Color fundus image · 45-degree field of view · 1515x1275:
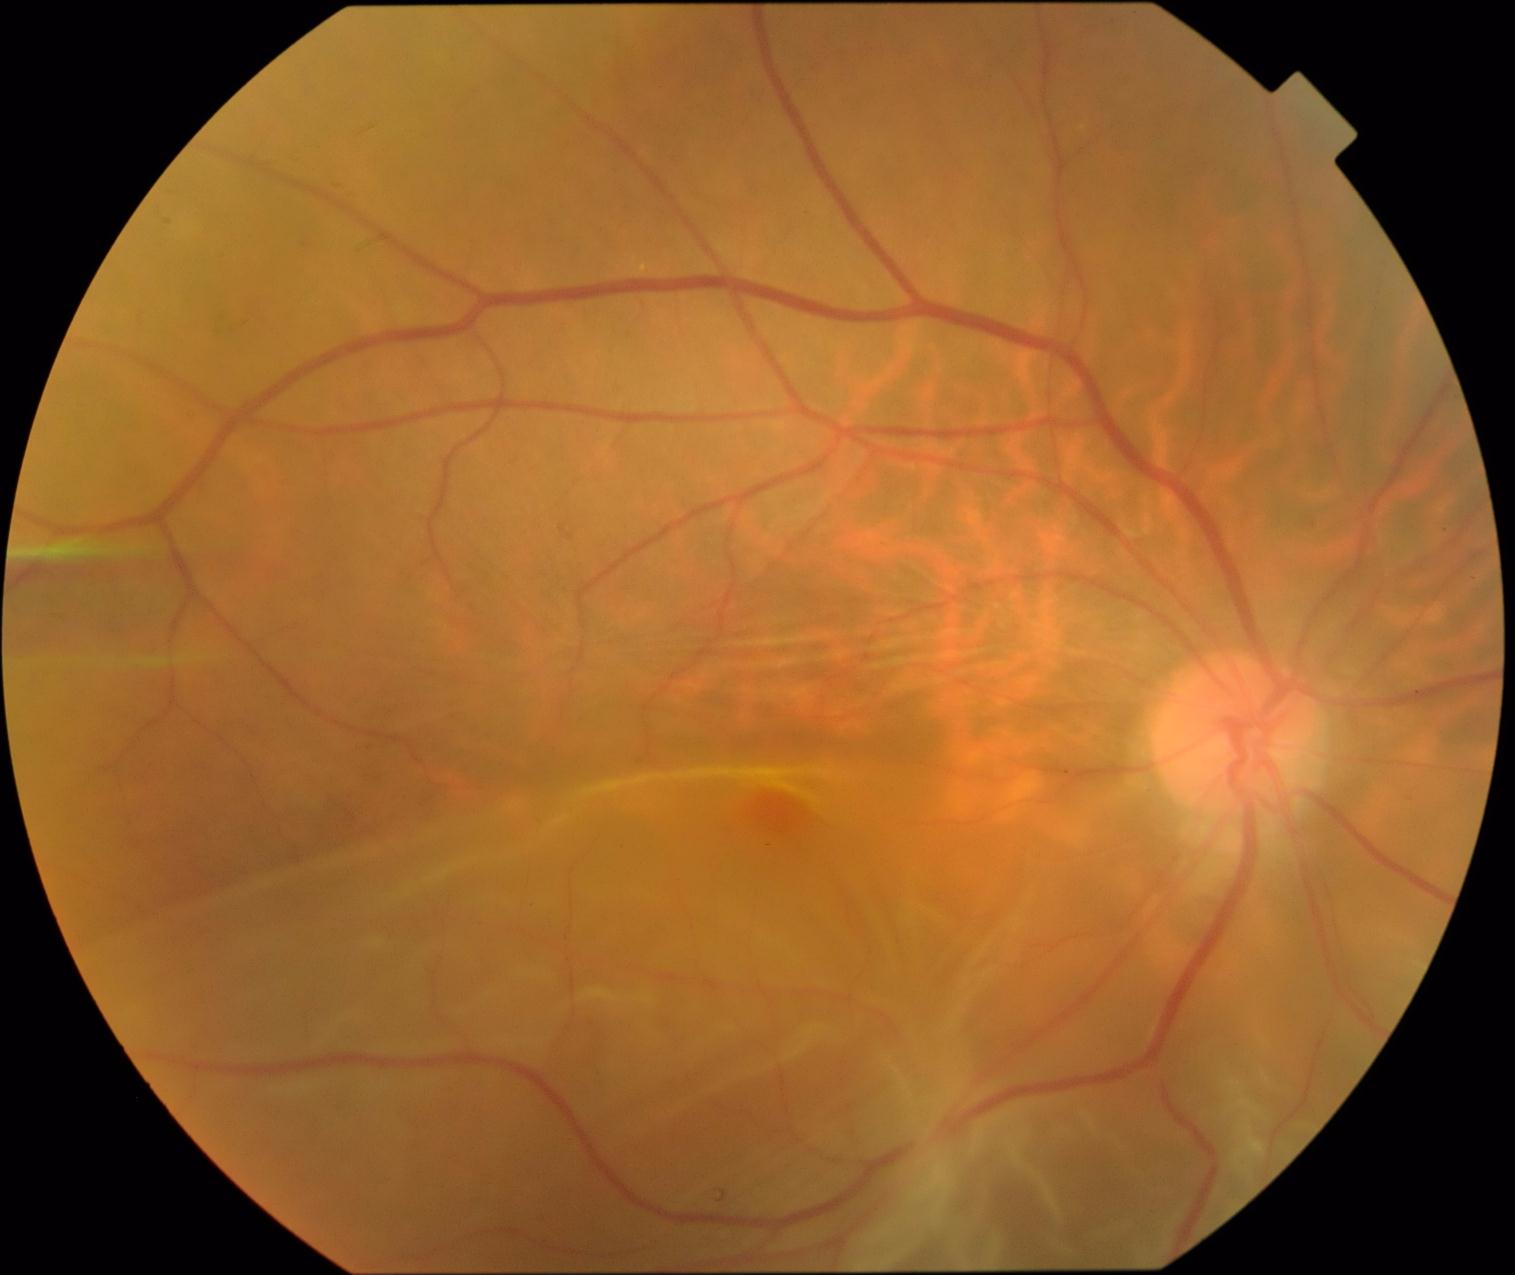
dr_category: proliferative diabetic retinopathy
dr_grade: 4